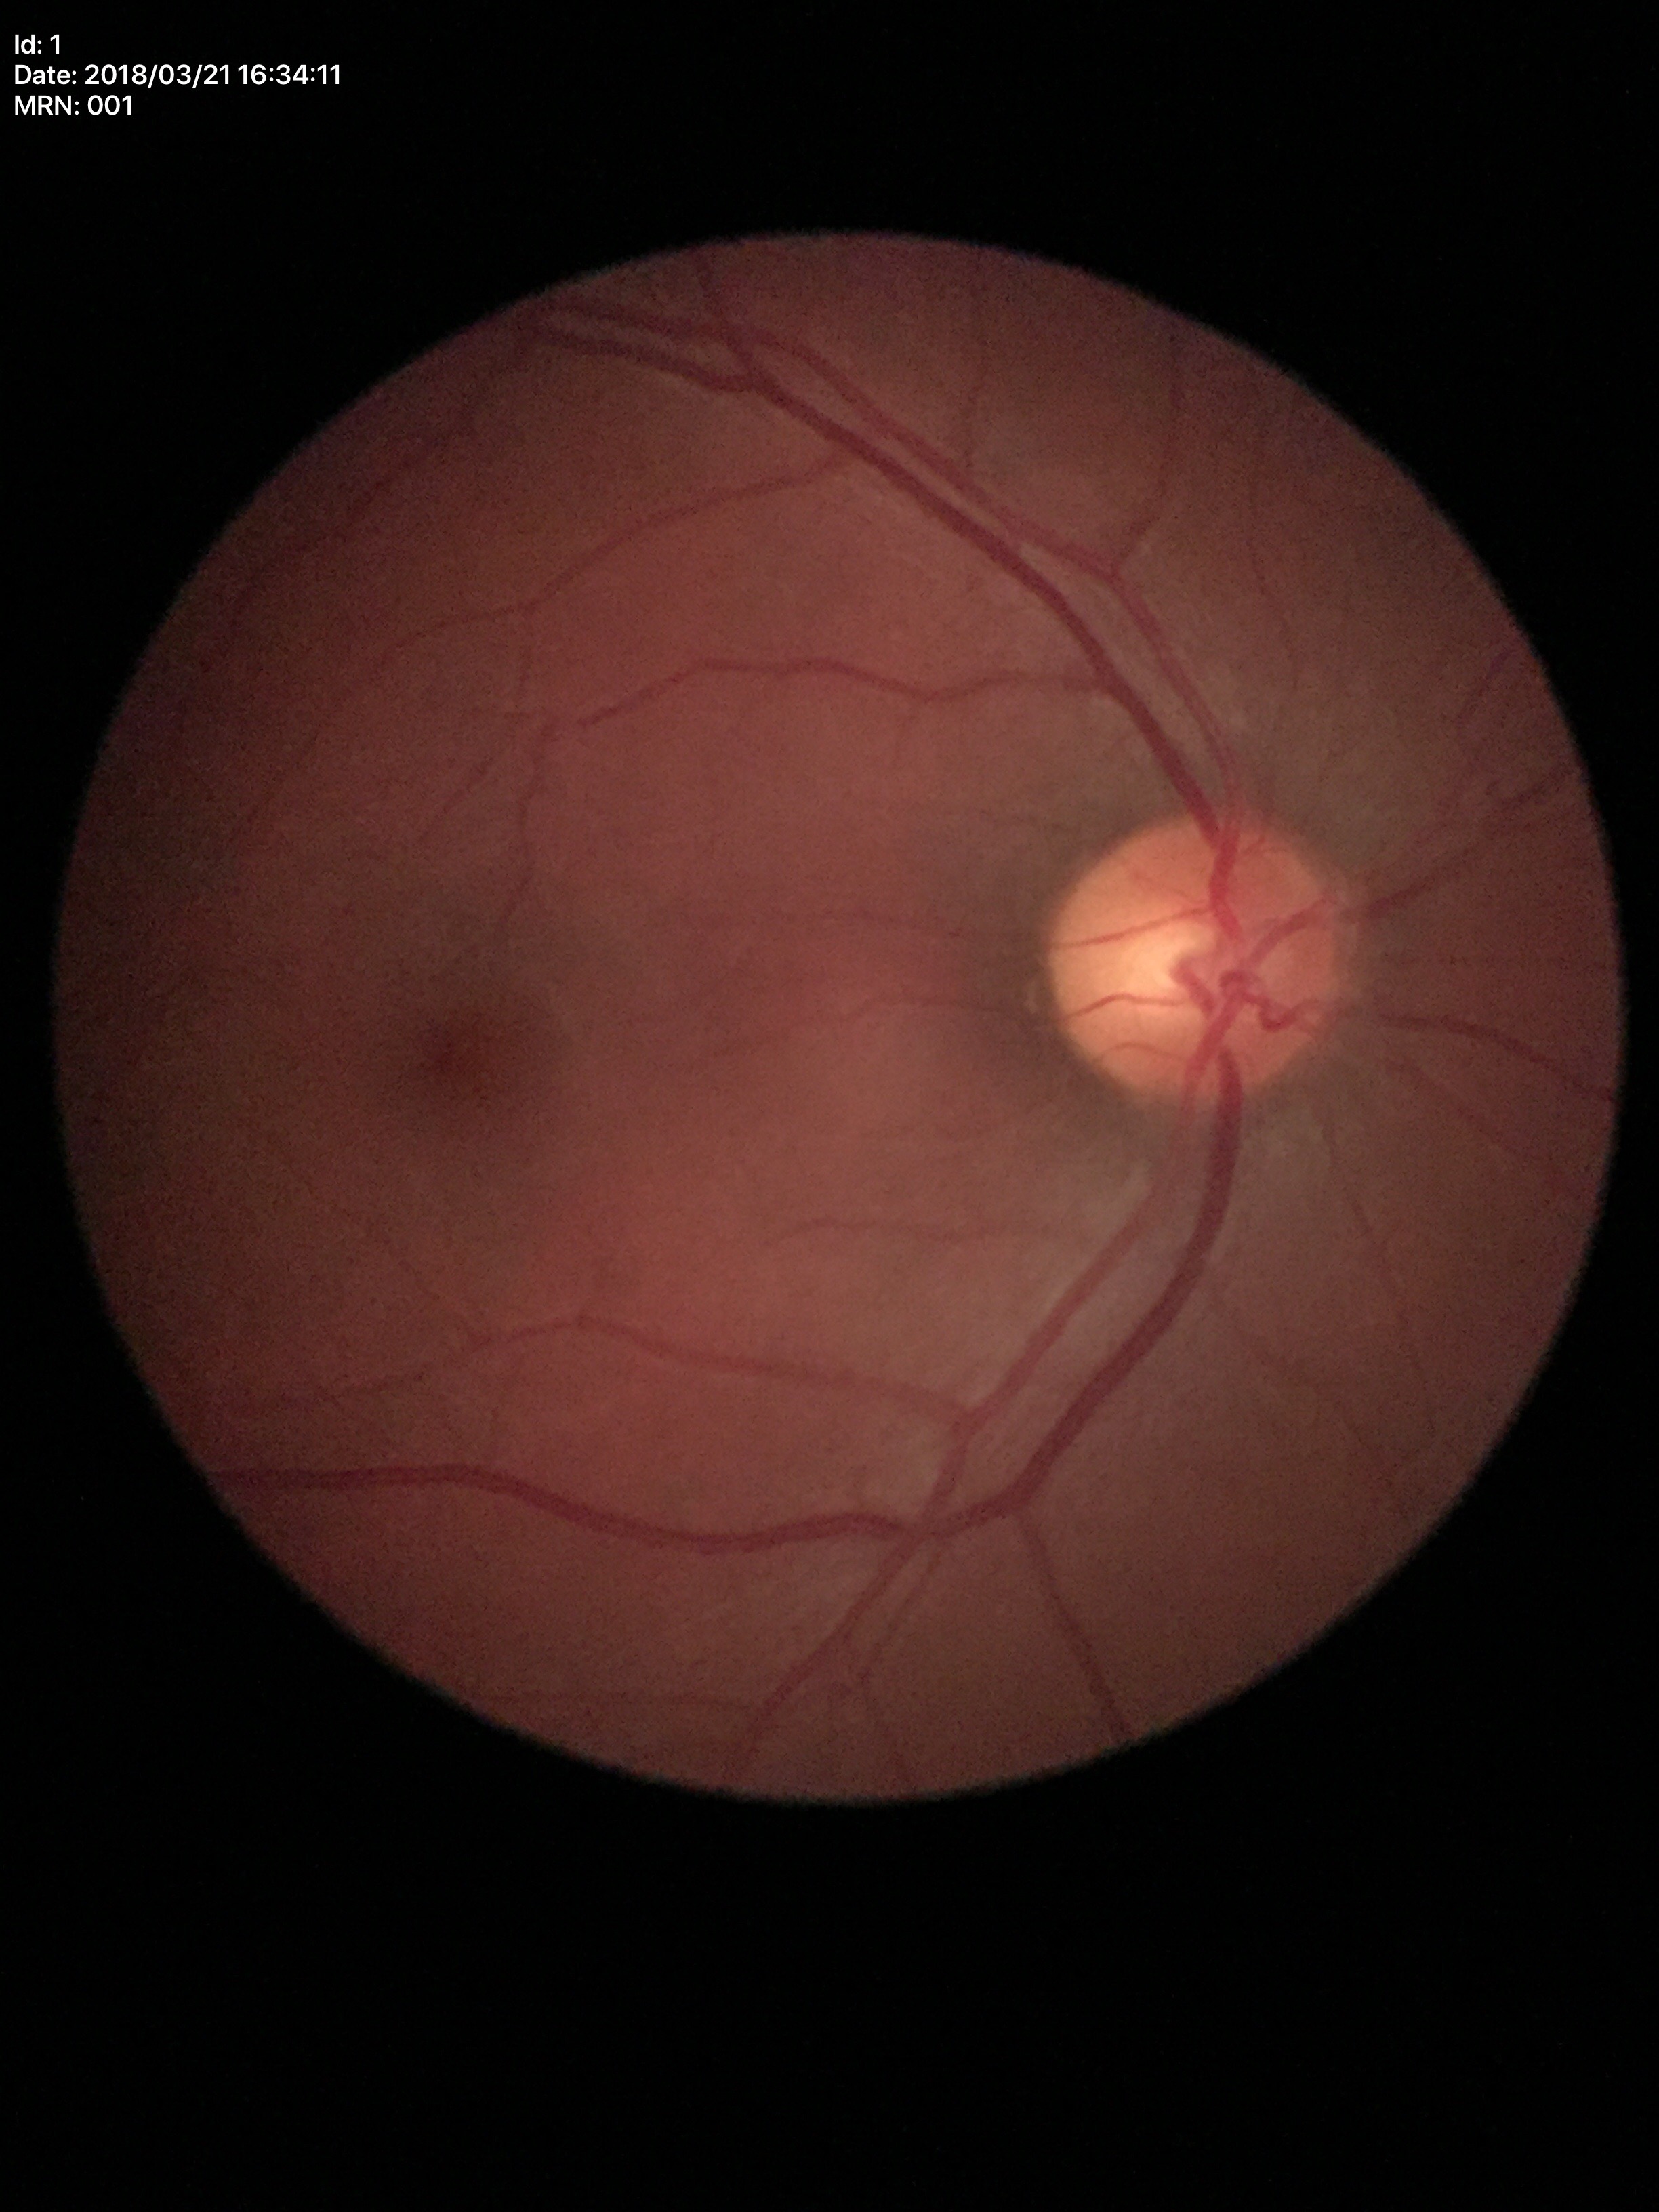 {"vcdr": "0.49", "glaucoma_decision": "not suspect"}